Posterior pole photograph; no pharmacologic dilation: 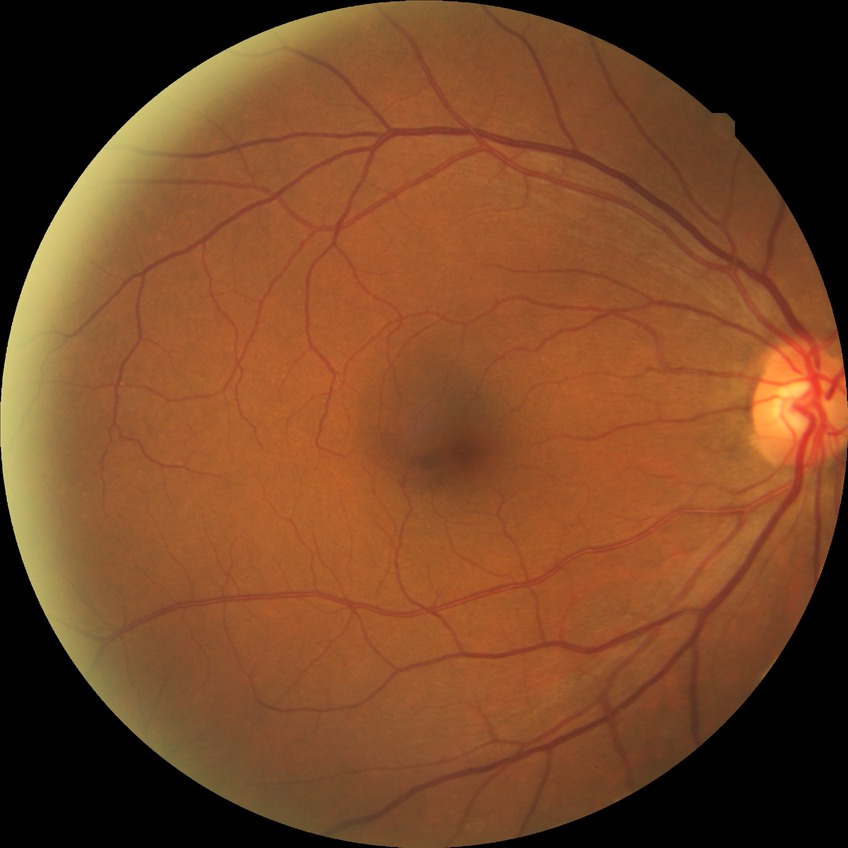 * diabetic retinopathy (DR): no diabetic retinopathy (NDR)